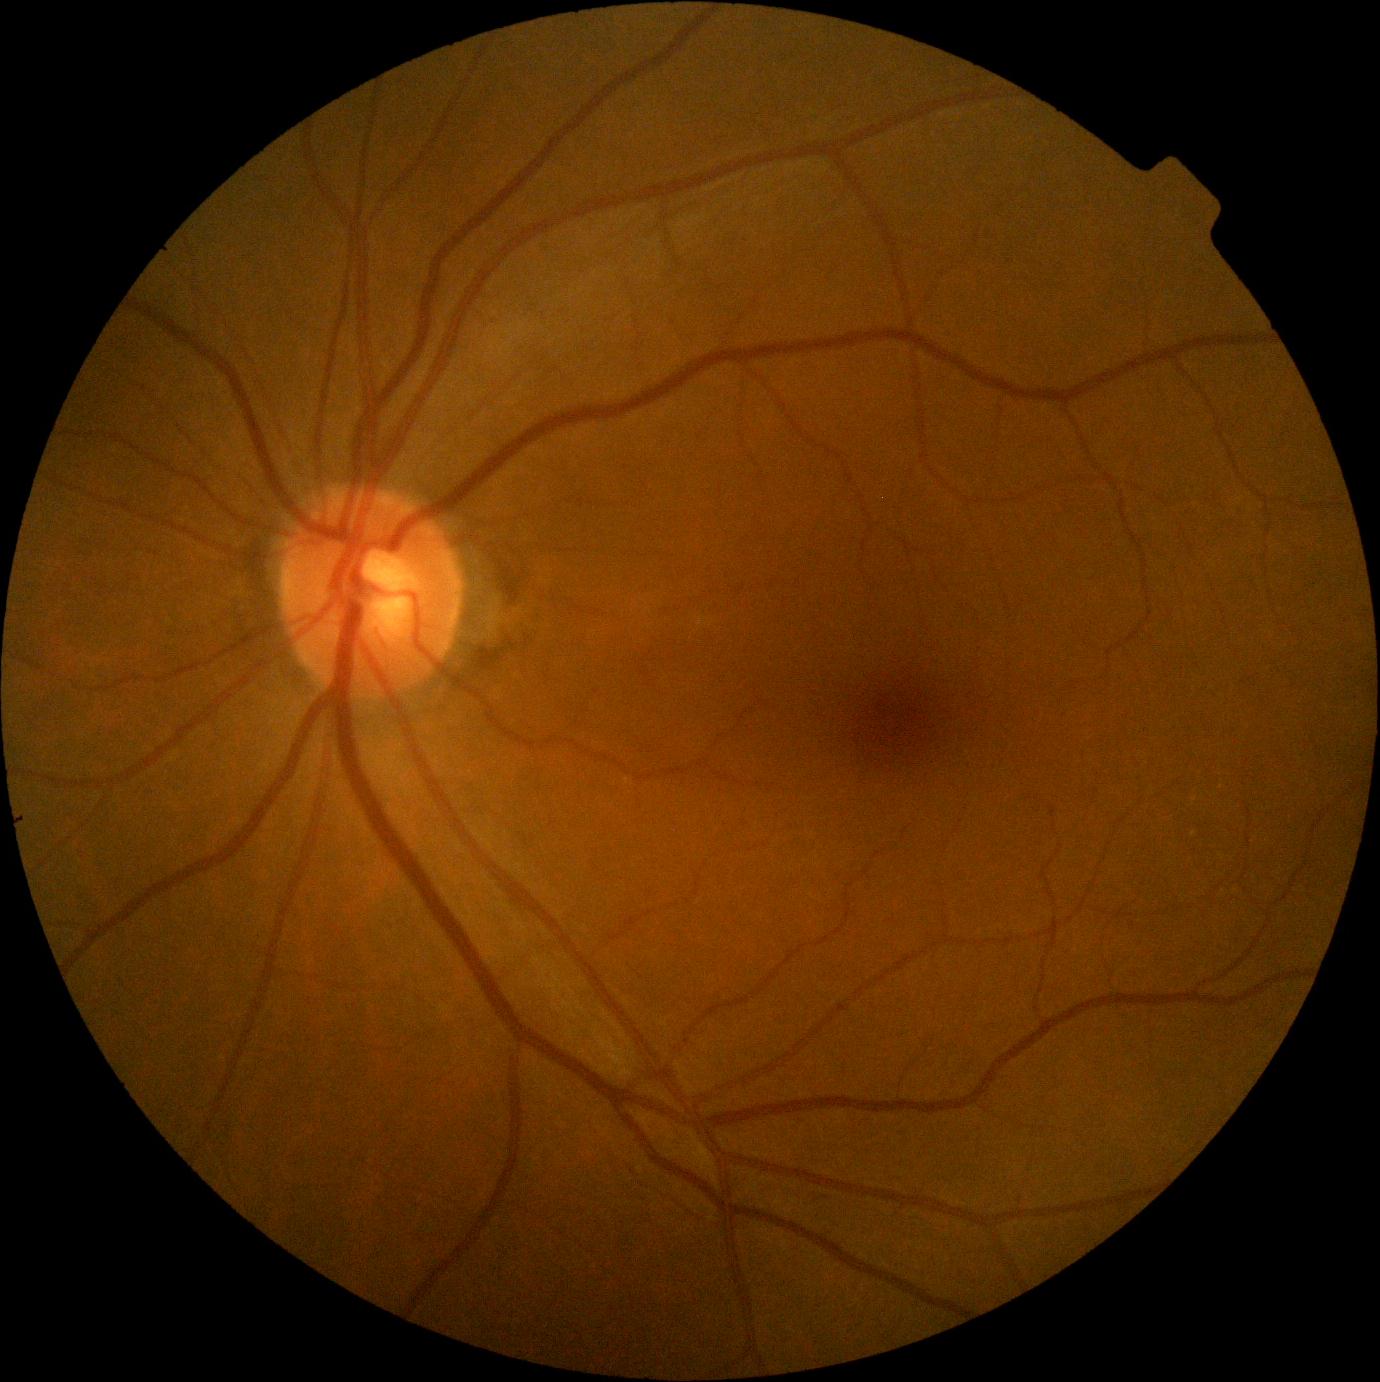 DR impression: no apparent DR, diabetic retinopathy severity: 0/4.